Corneal thickness 562 µm; captured without pupil dilation; woman; IOP 20 mmHg by non-contact tonometry:
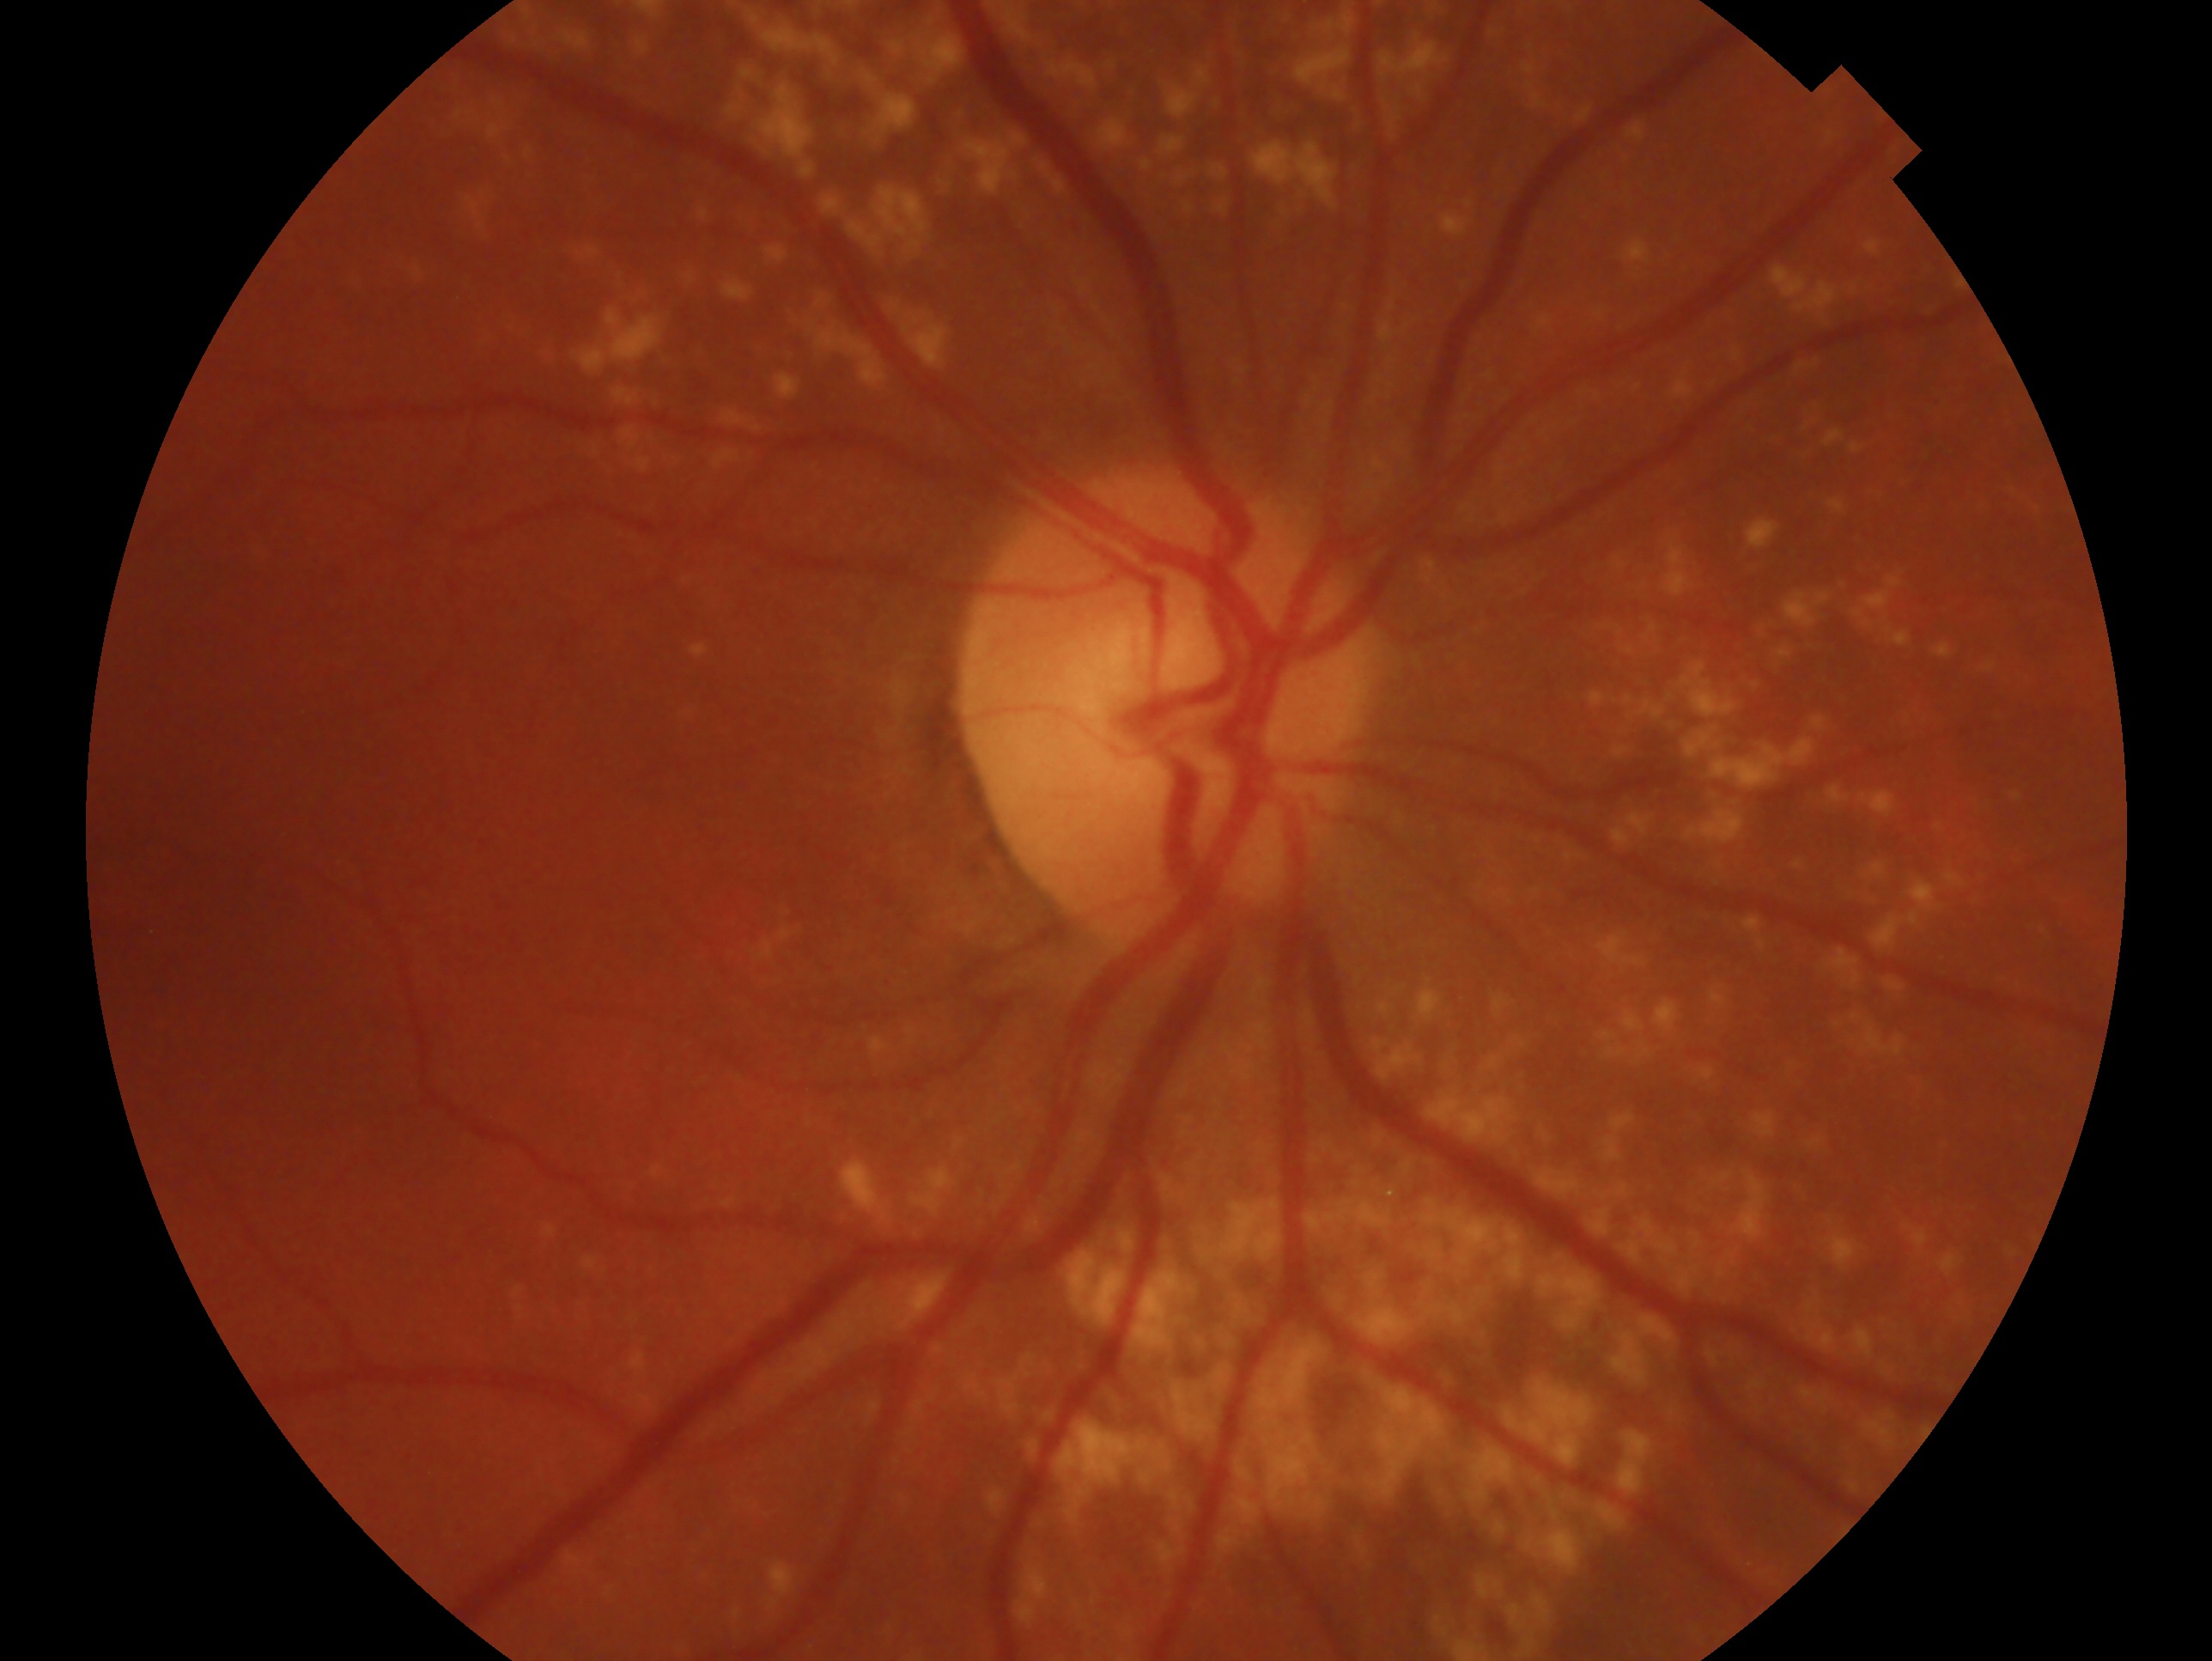
glaucoma_dx: no glaucoma
eye: OD